Without pupil dilation · 848 x 848 pixels · color fundus image: 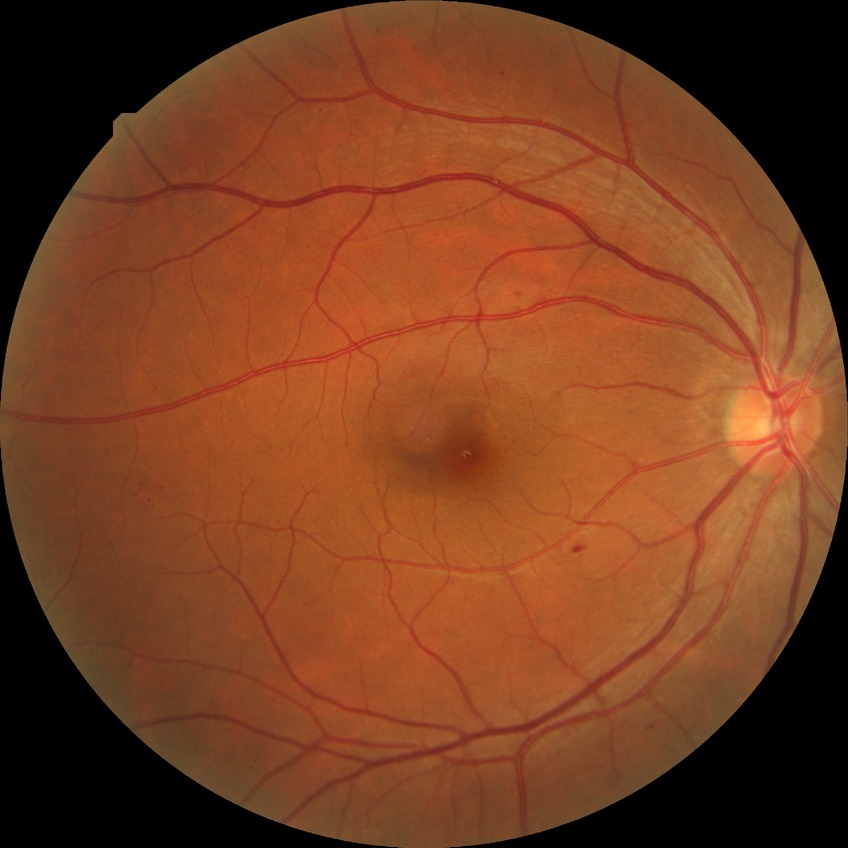

DR: SDR.